45° field of view; 2352 x 1568 pixels; color fundus image
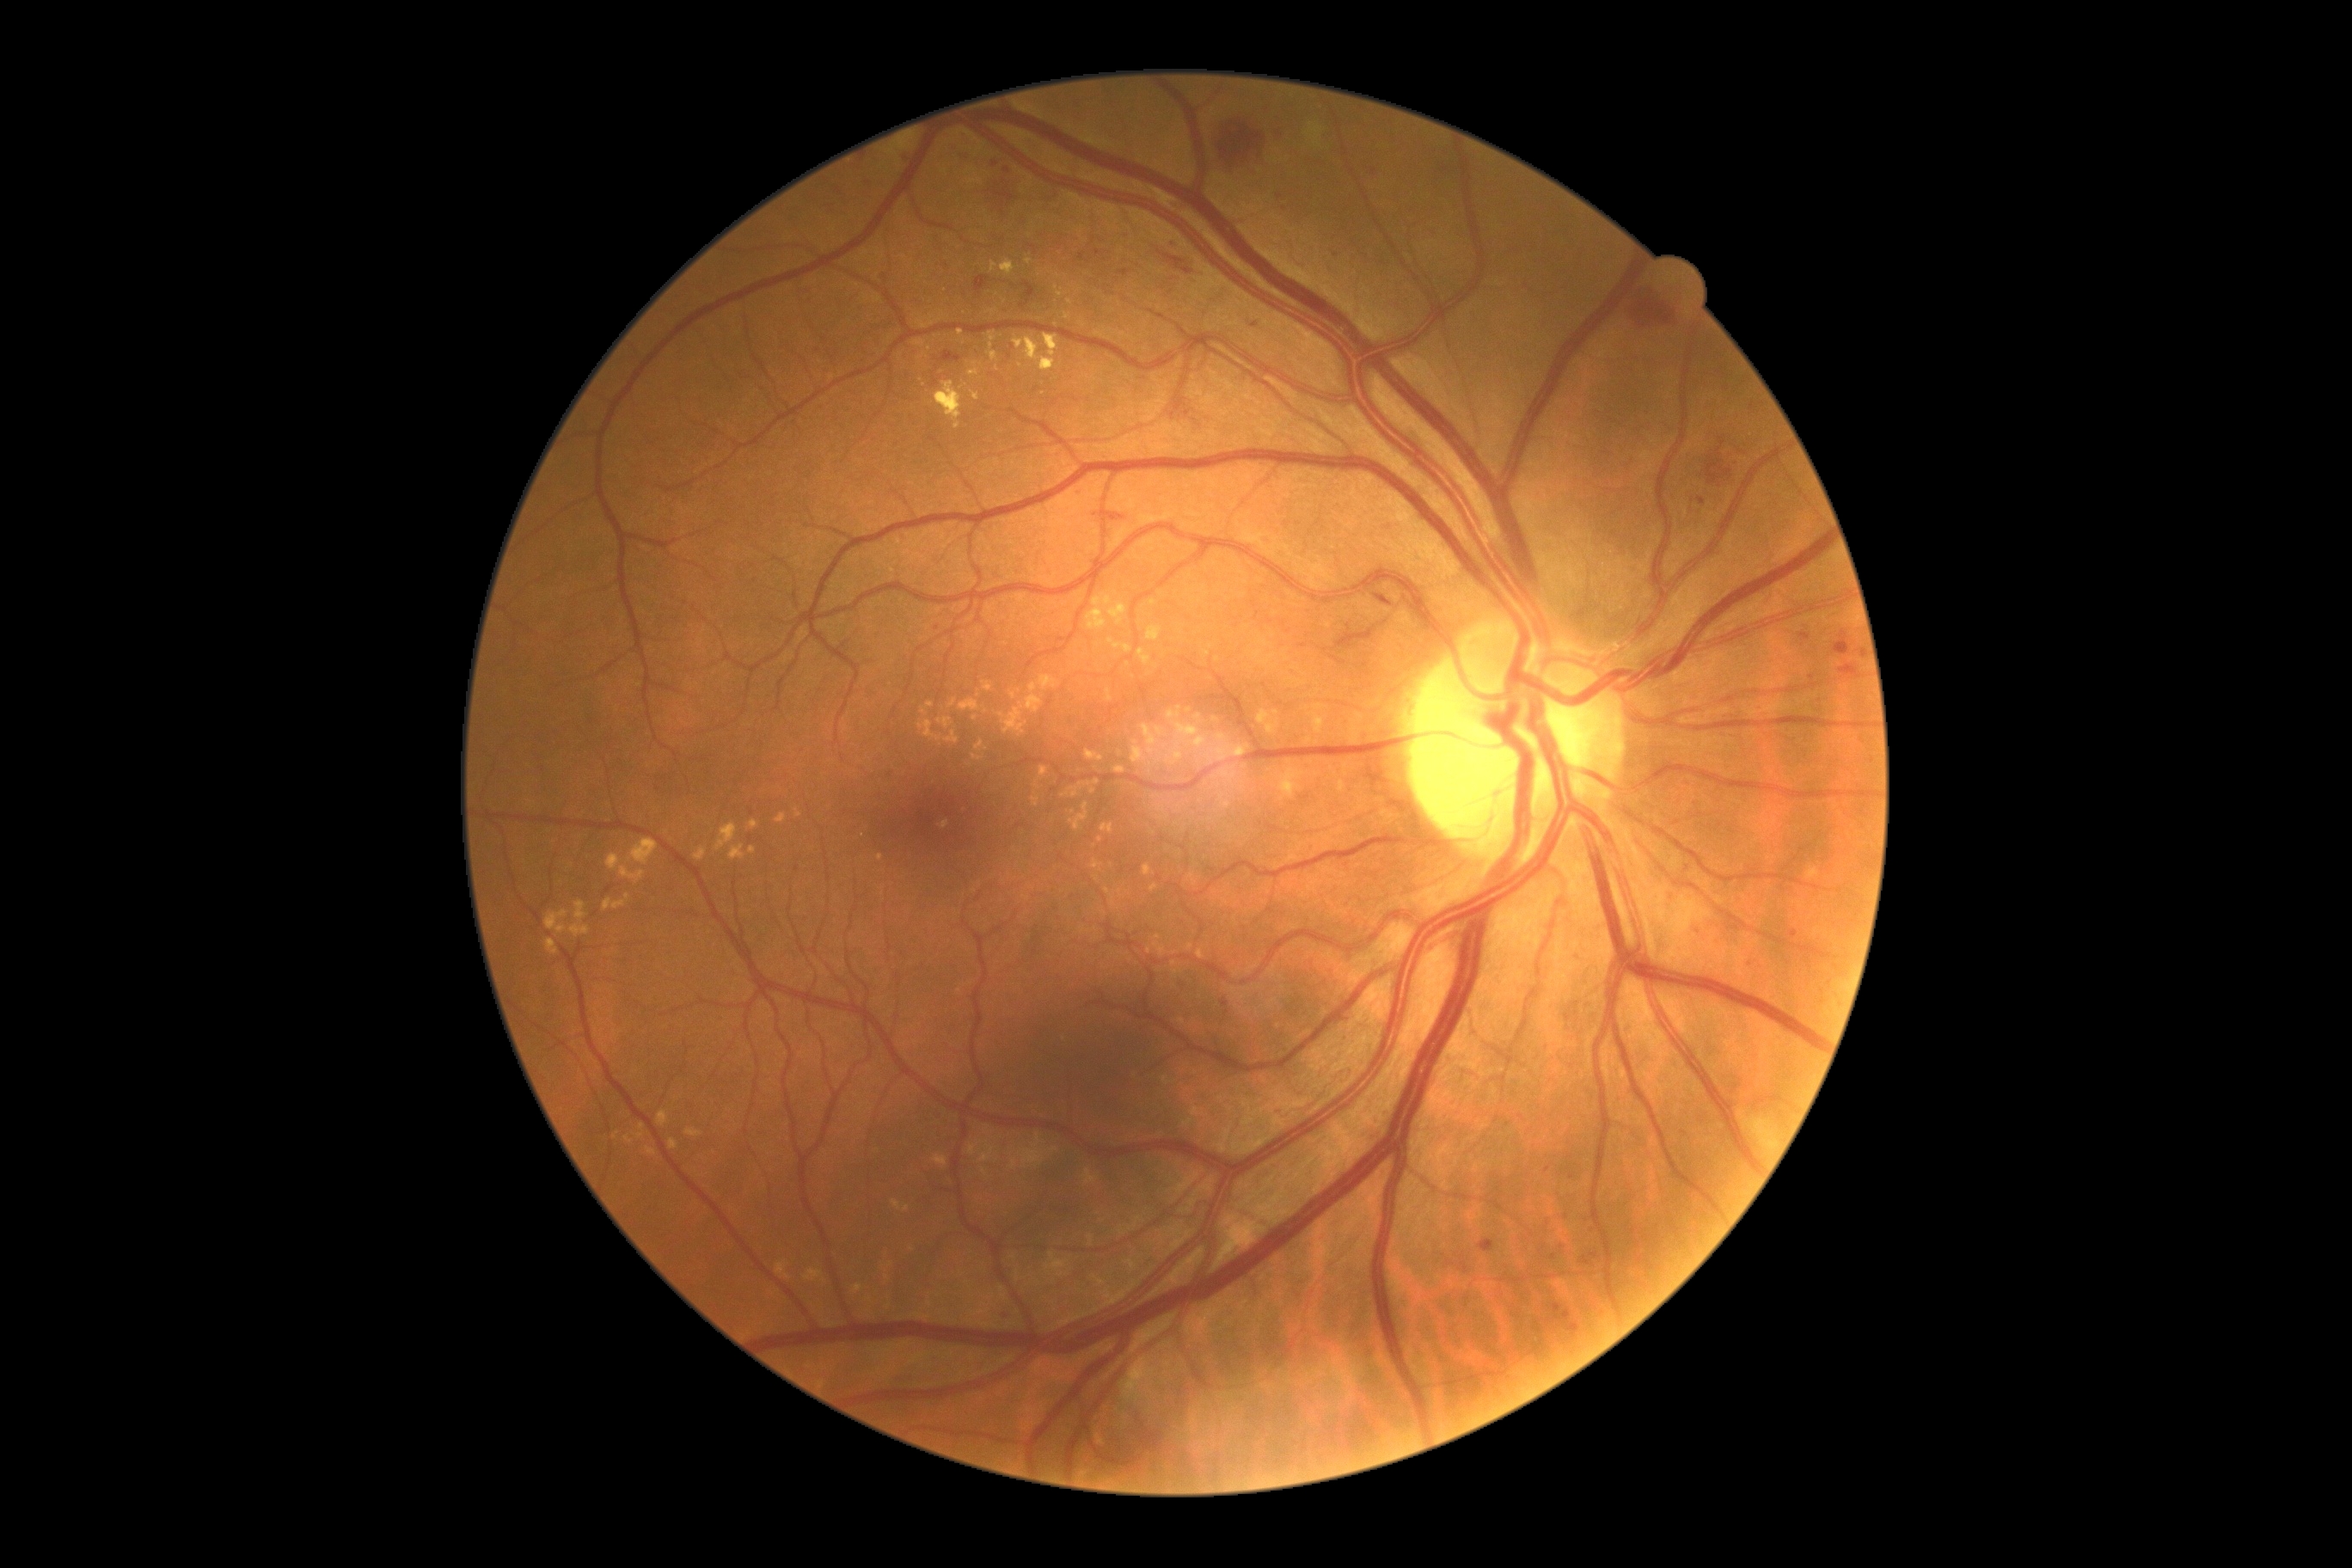

DR severity@grade 2 (moderate NPDR).